45° field of view:
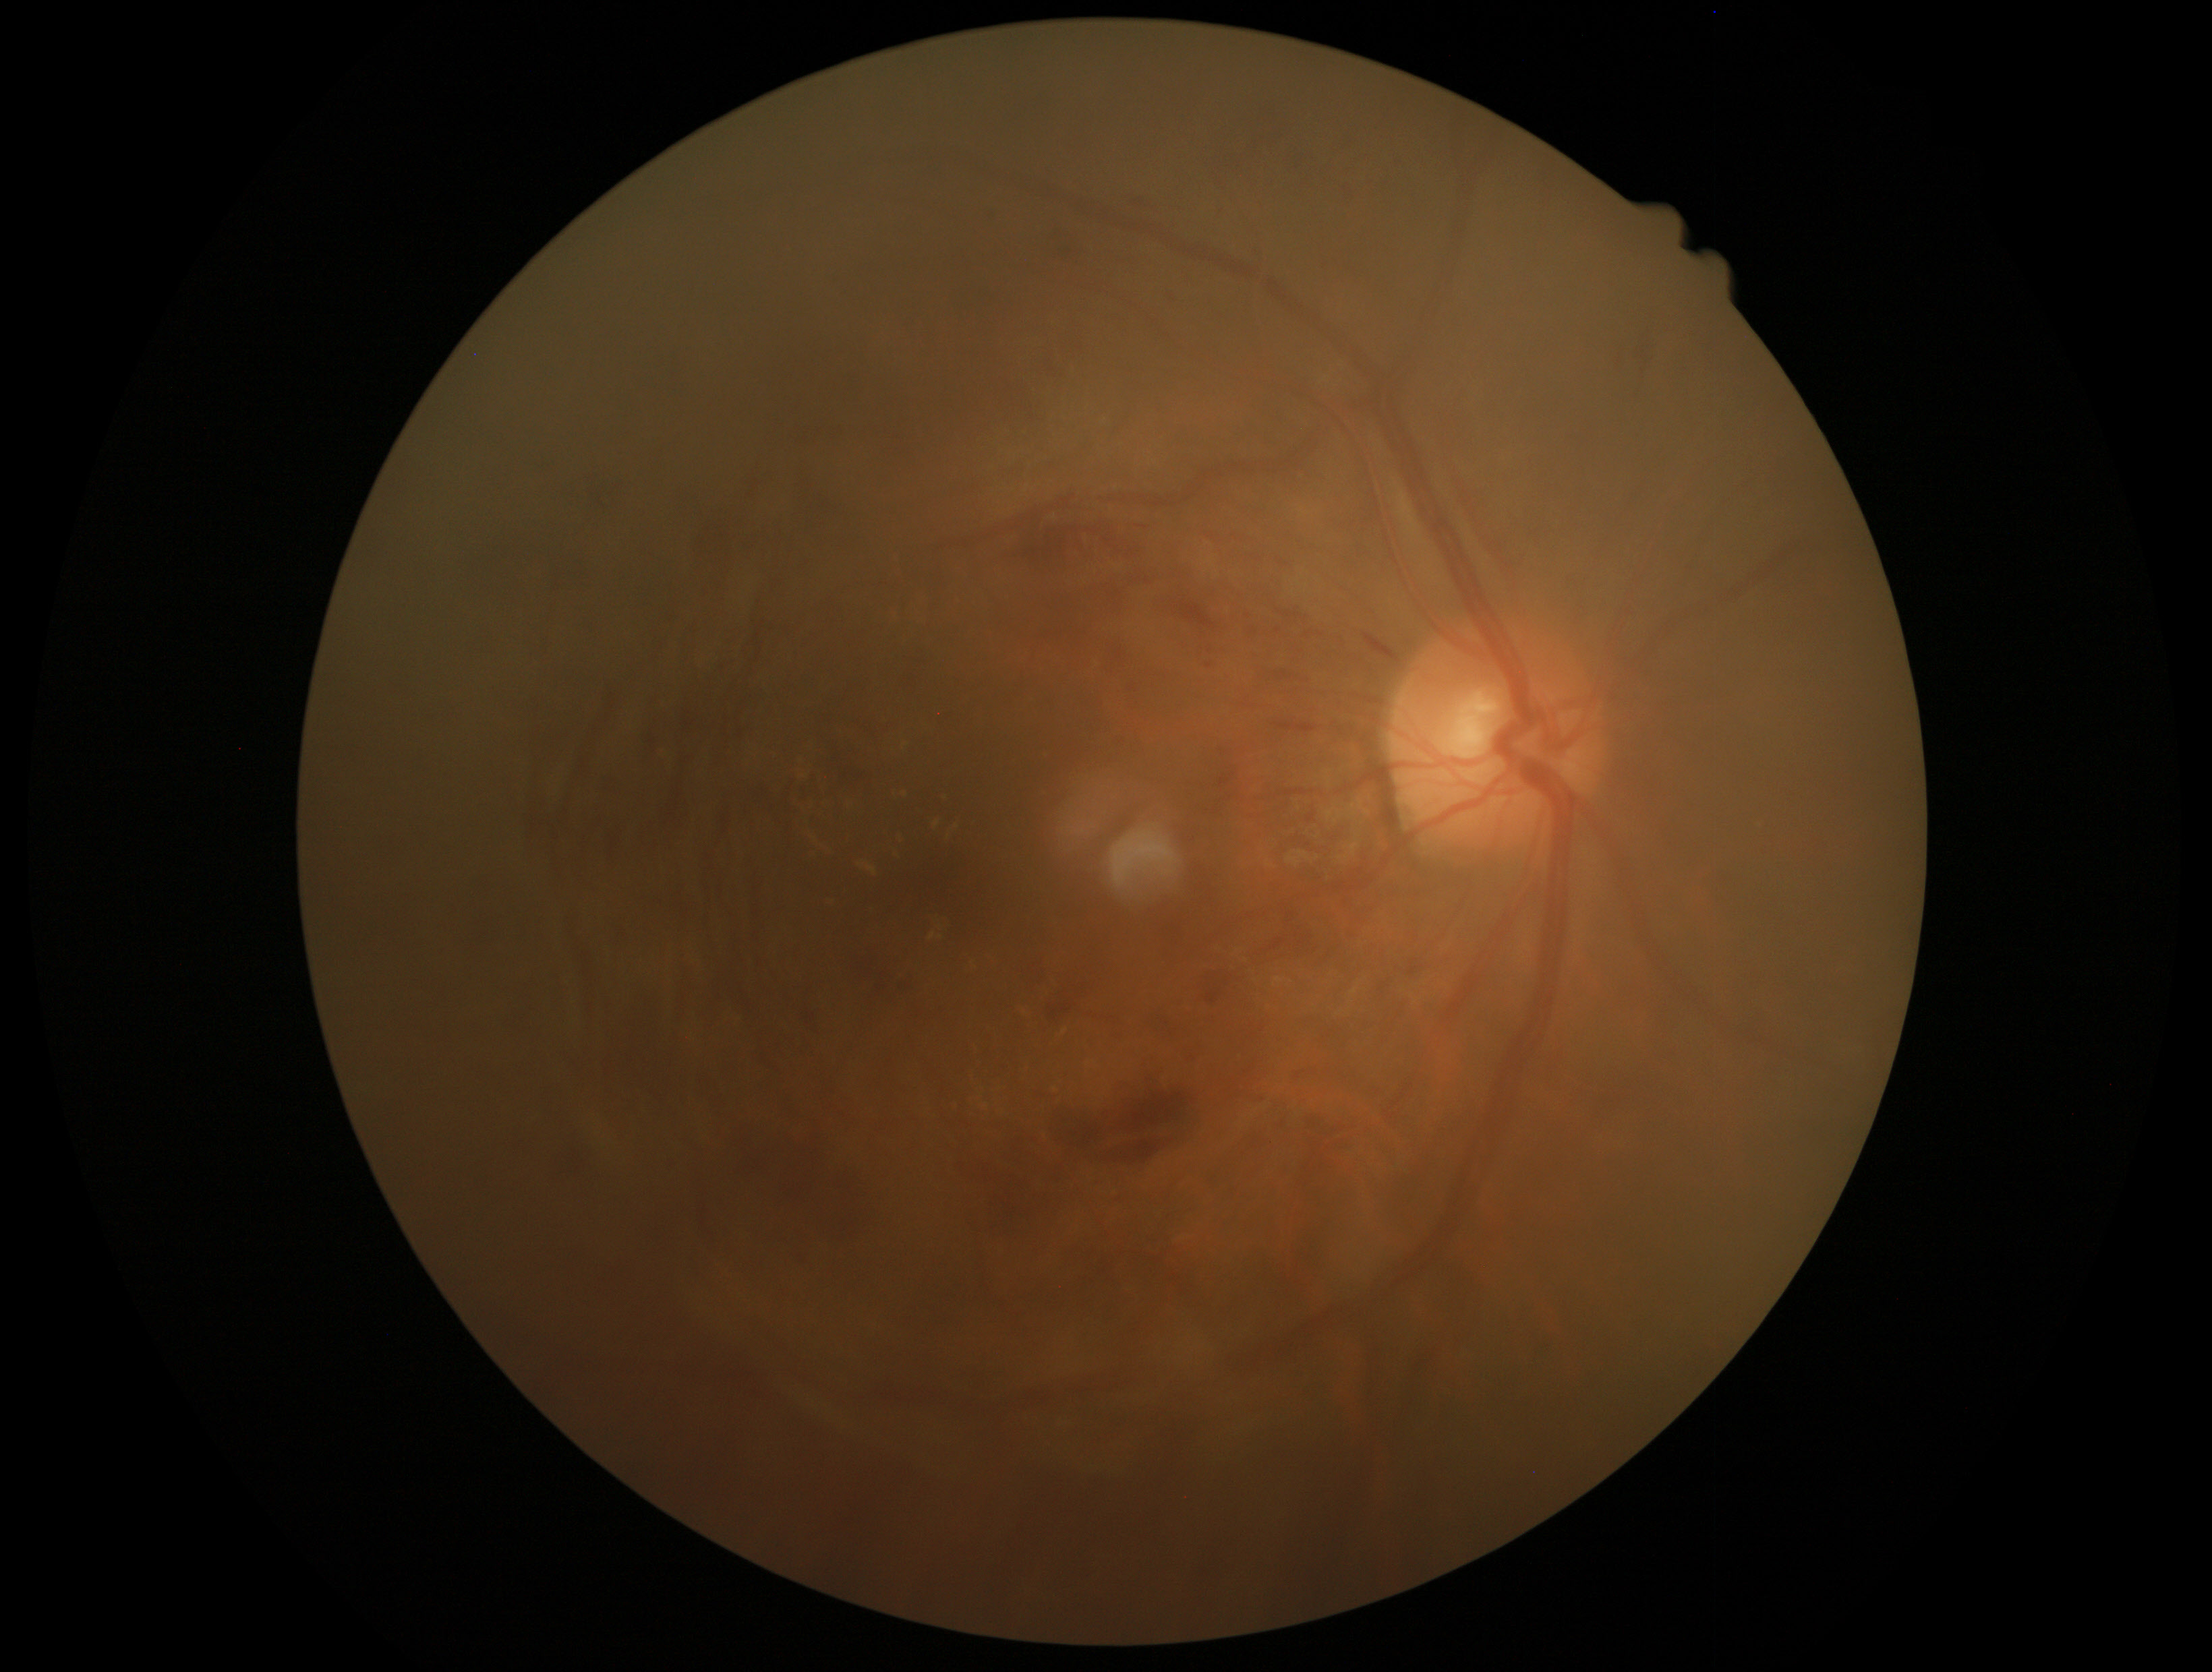
Diabetic retinopathy (DR): 2/4.